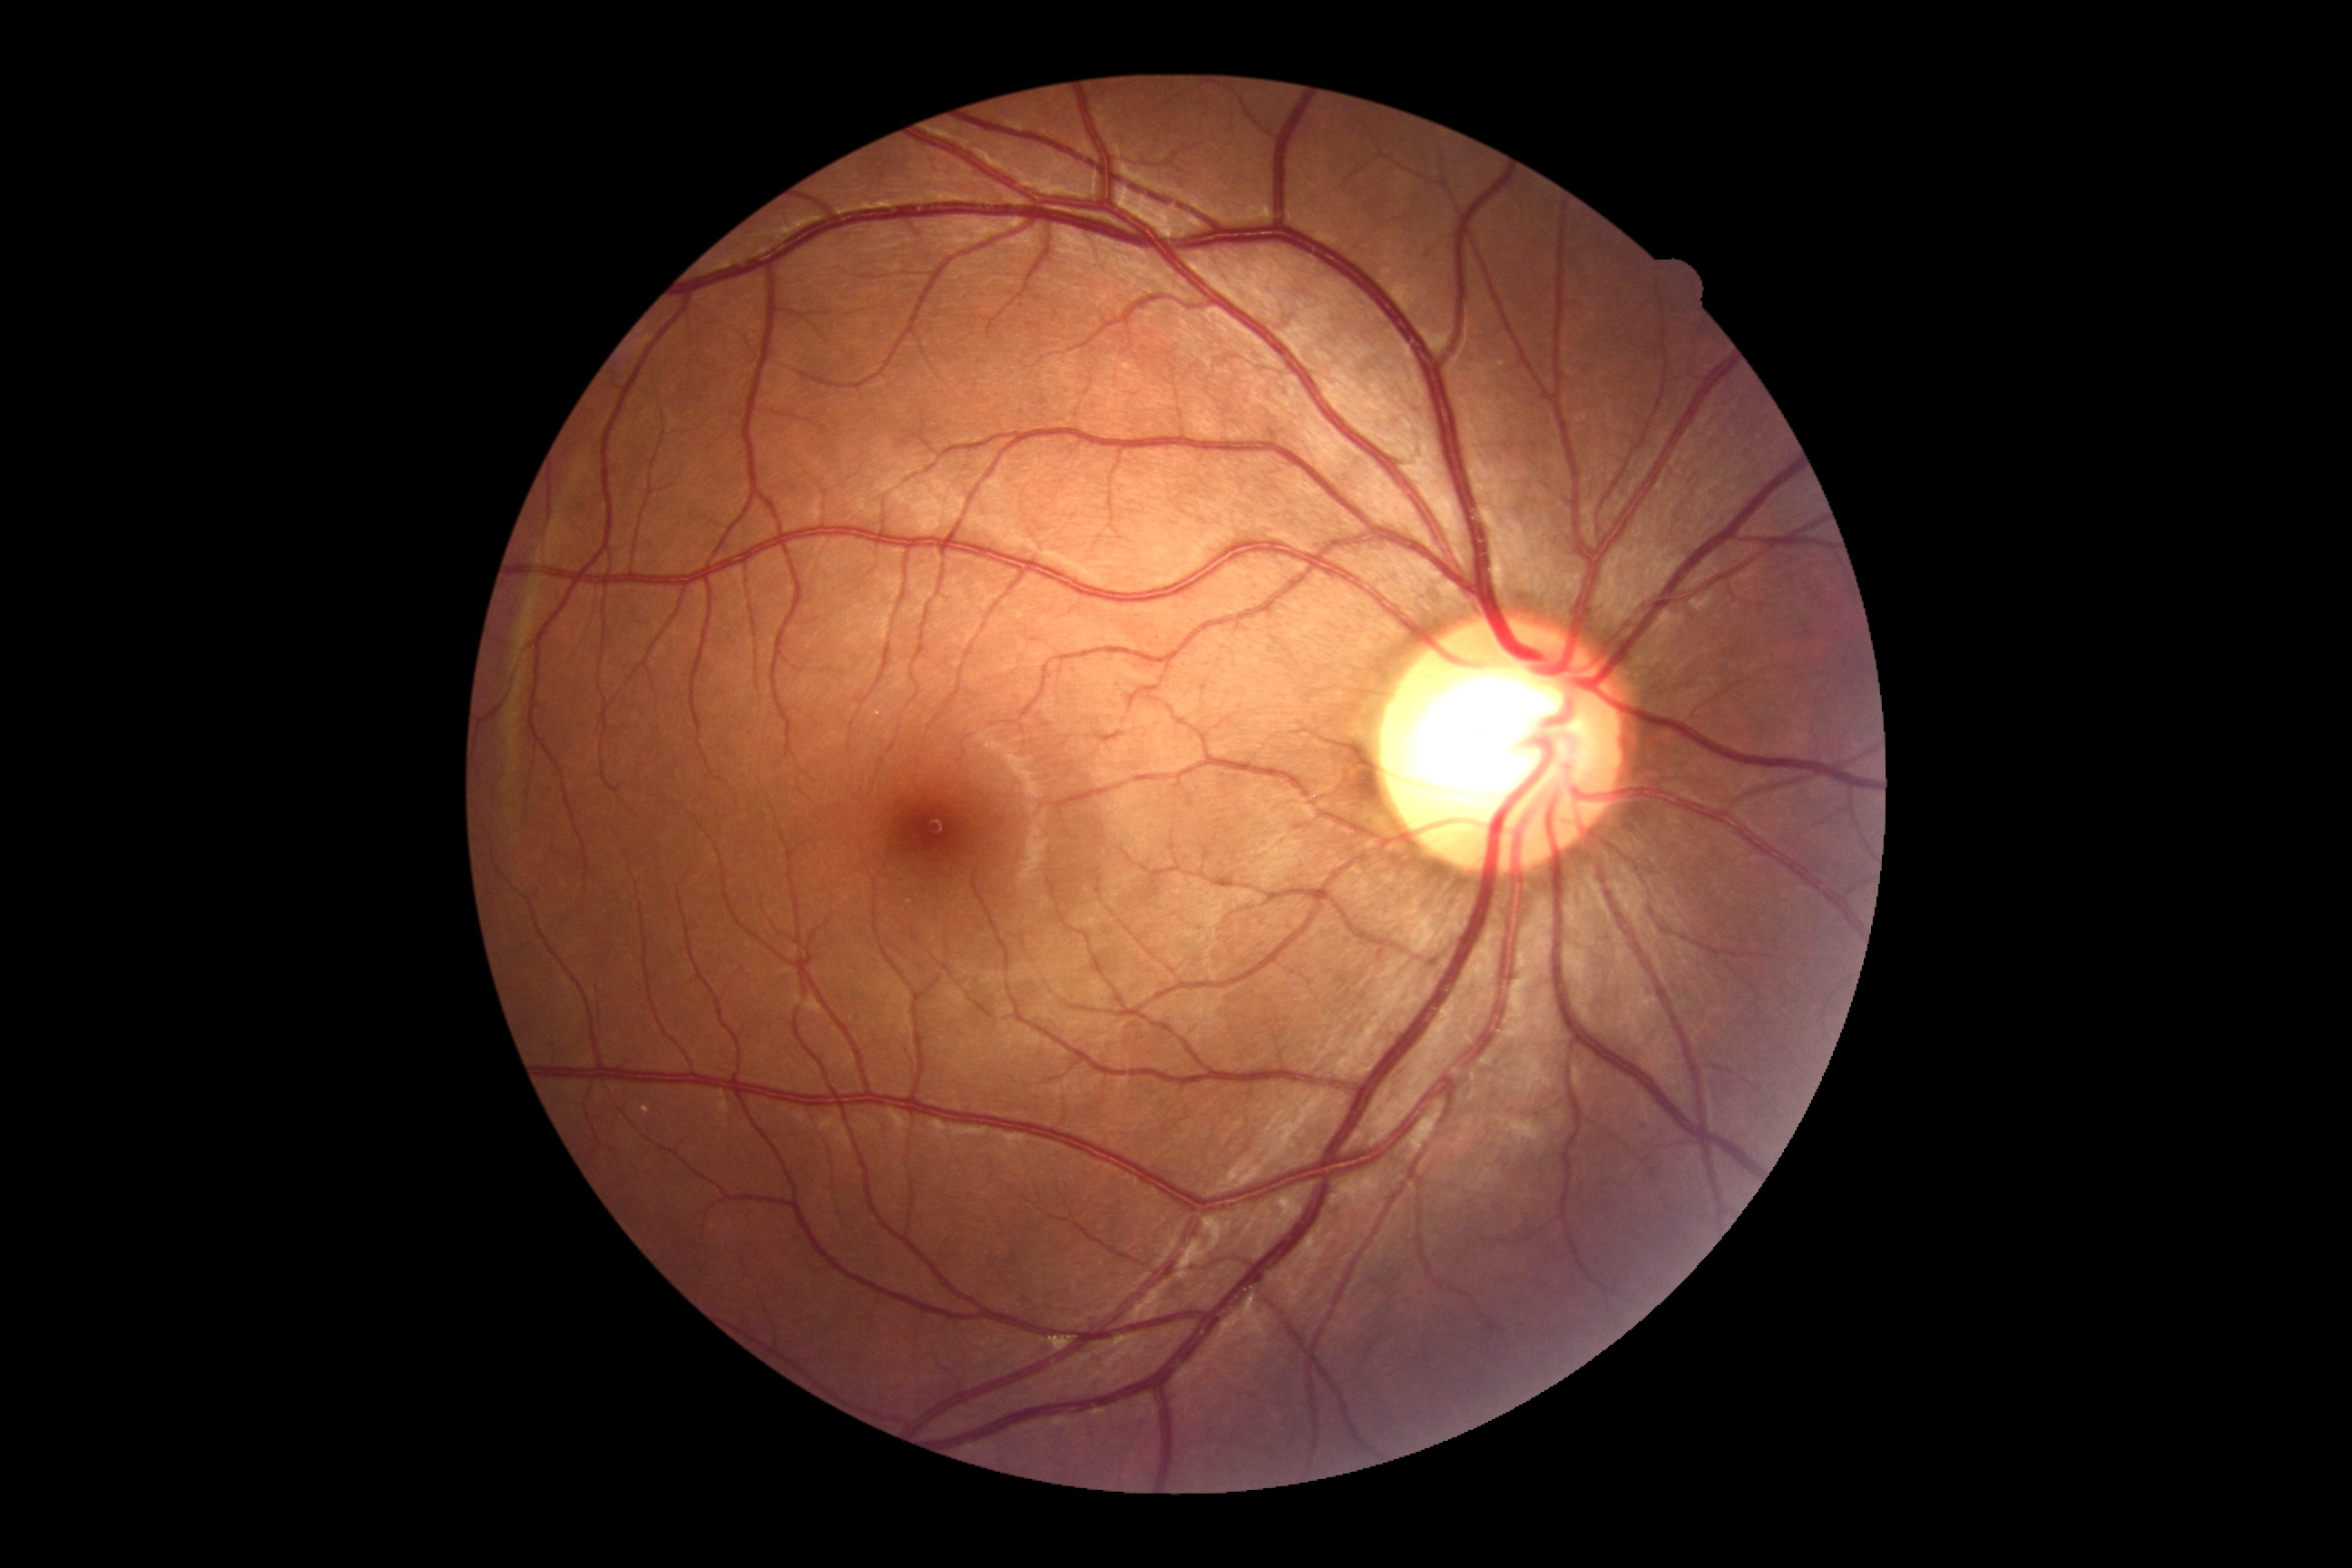

Retinopathy is 0.